Age 54; pachymetry 505 µm; refraction: +0 -0.25 x 150 — 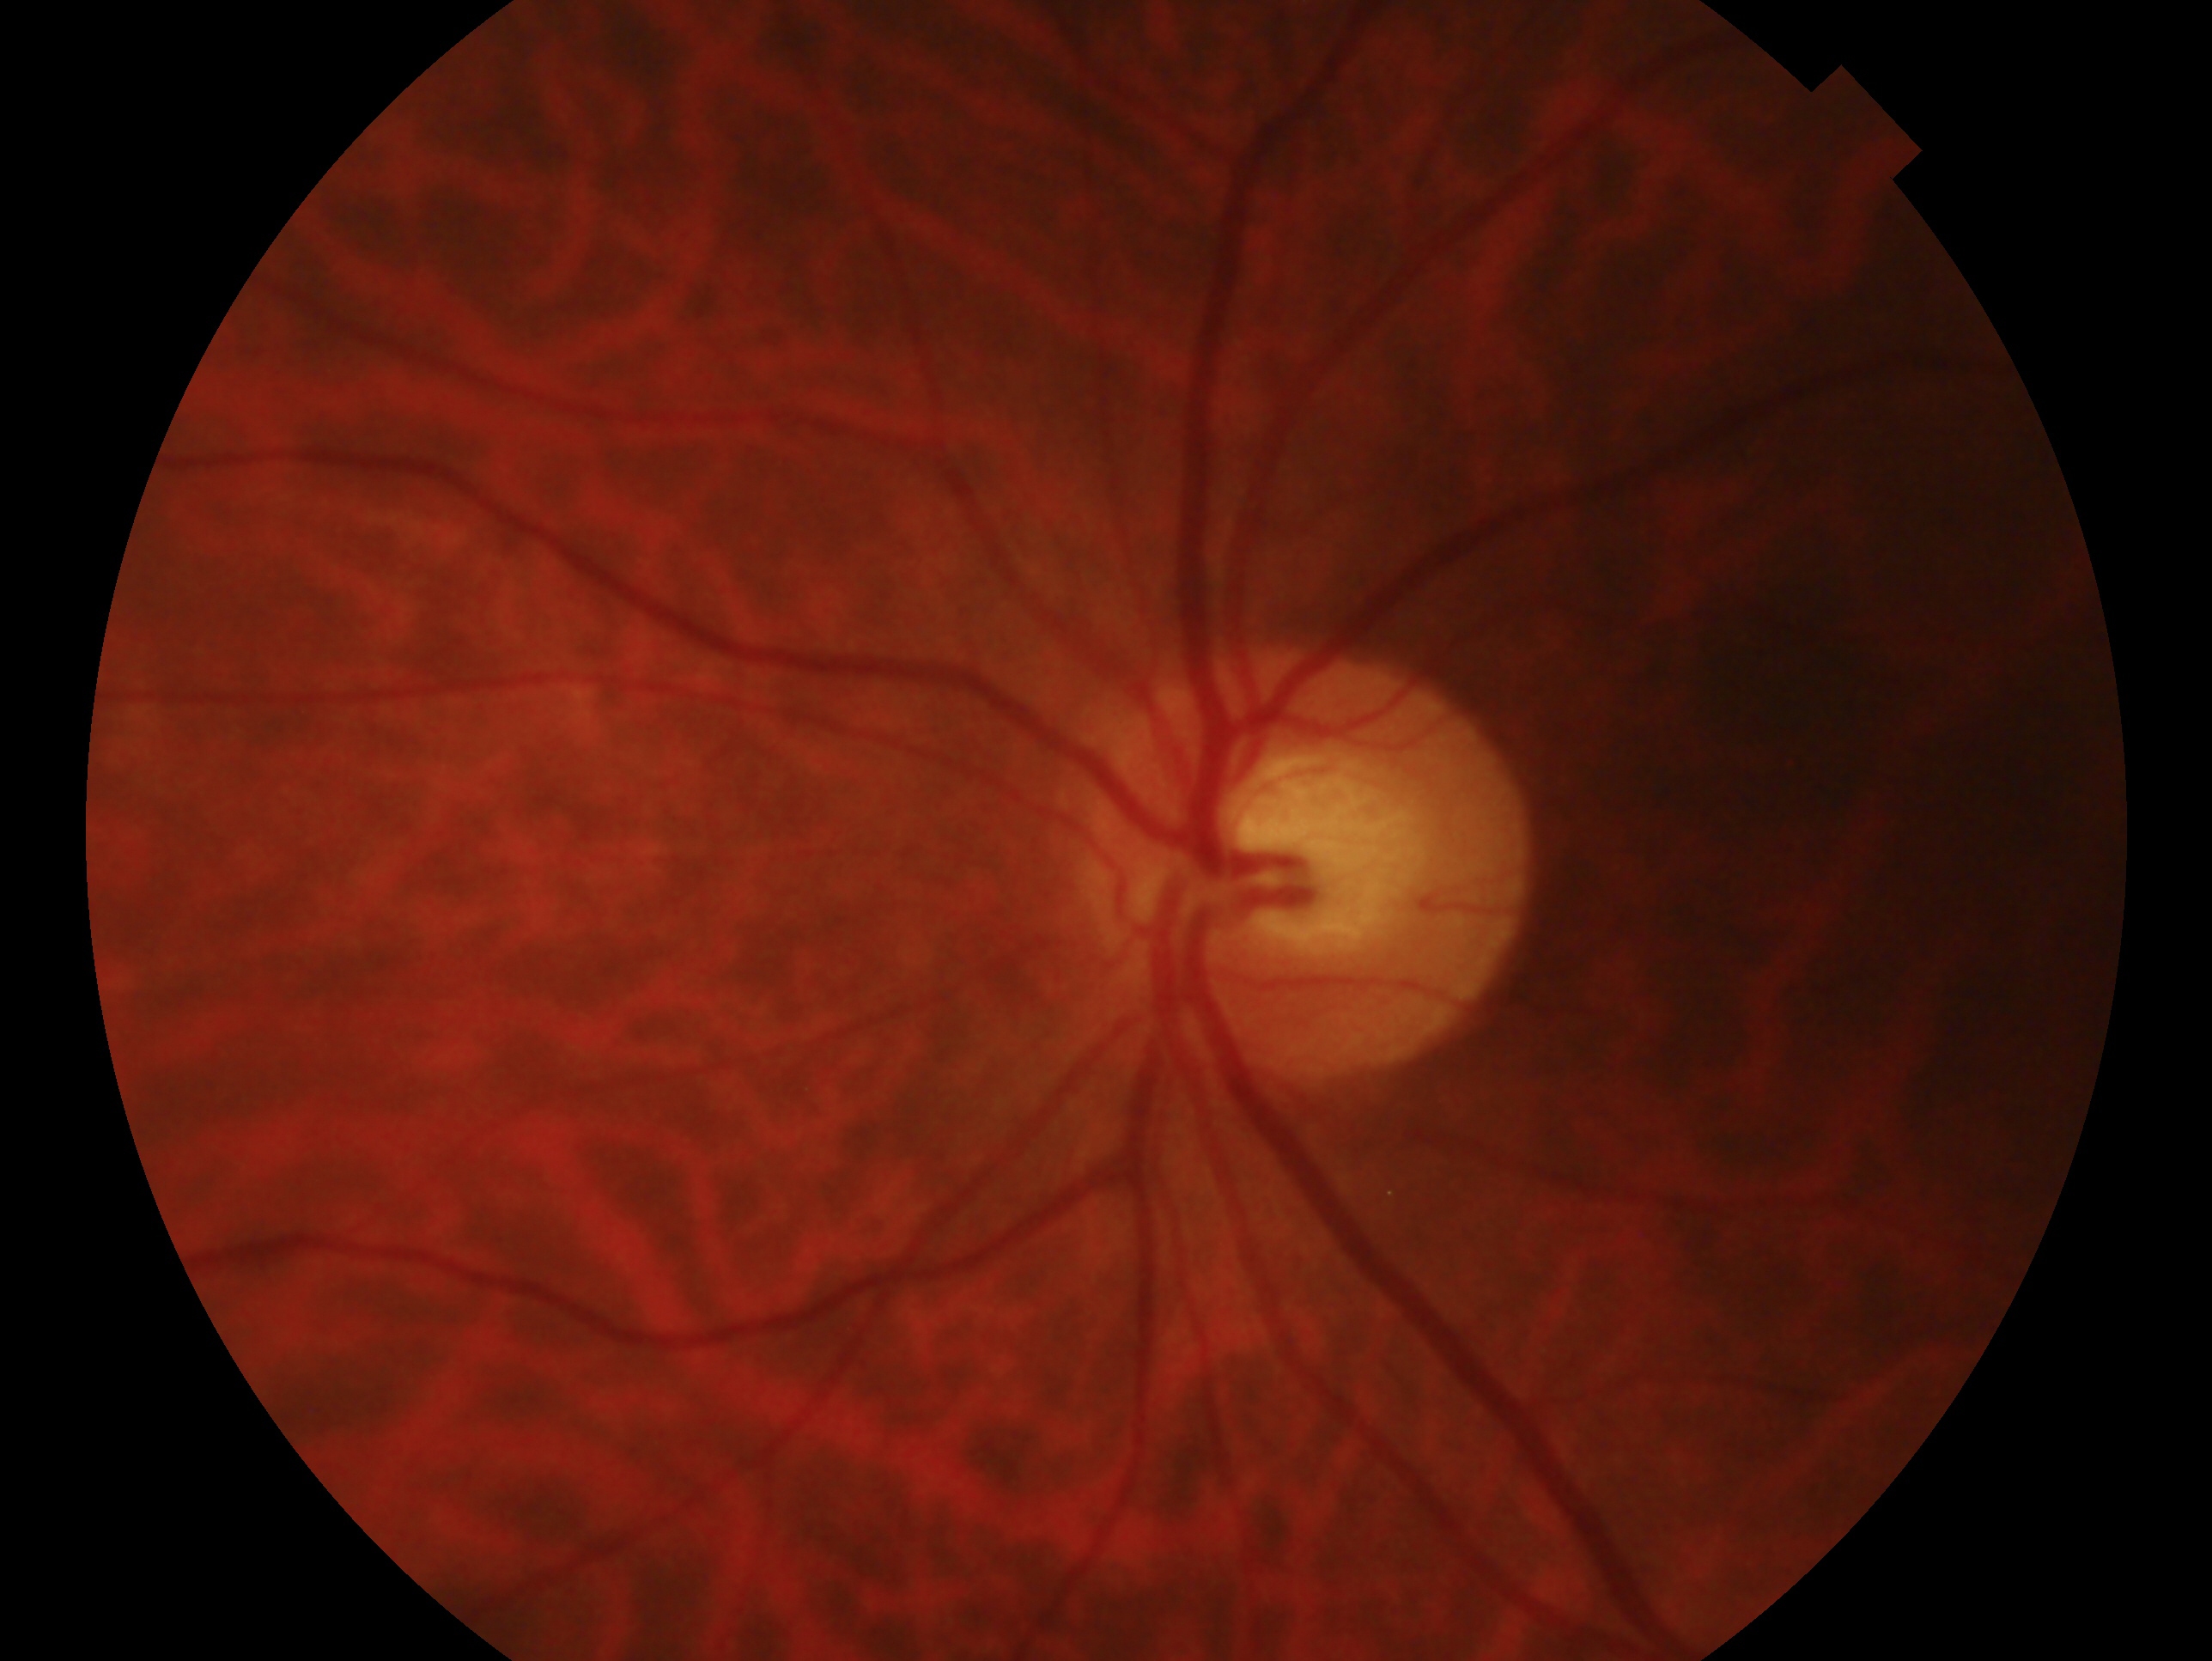
Q: Which eye is imaged?
A: oculus sinister
Q: Glaucoma assessment?
A: negative for glaucoma